68 years old; pachymetry 537 µm
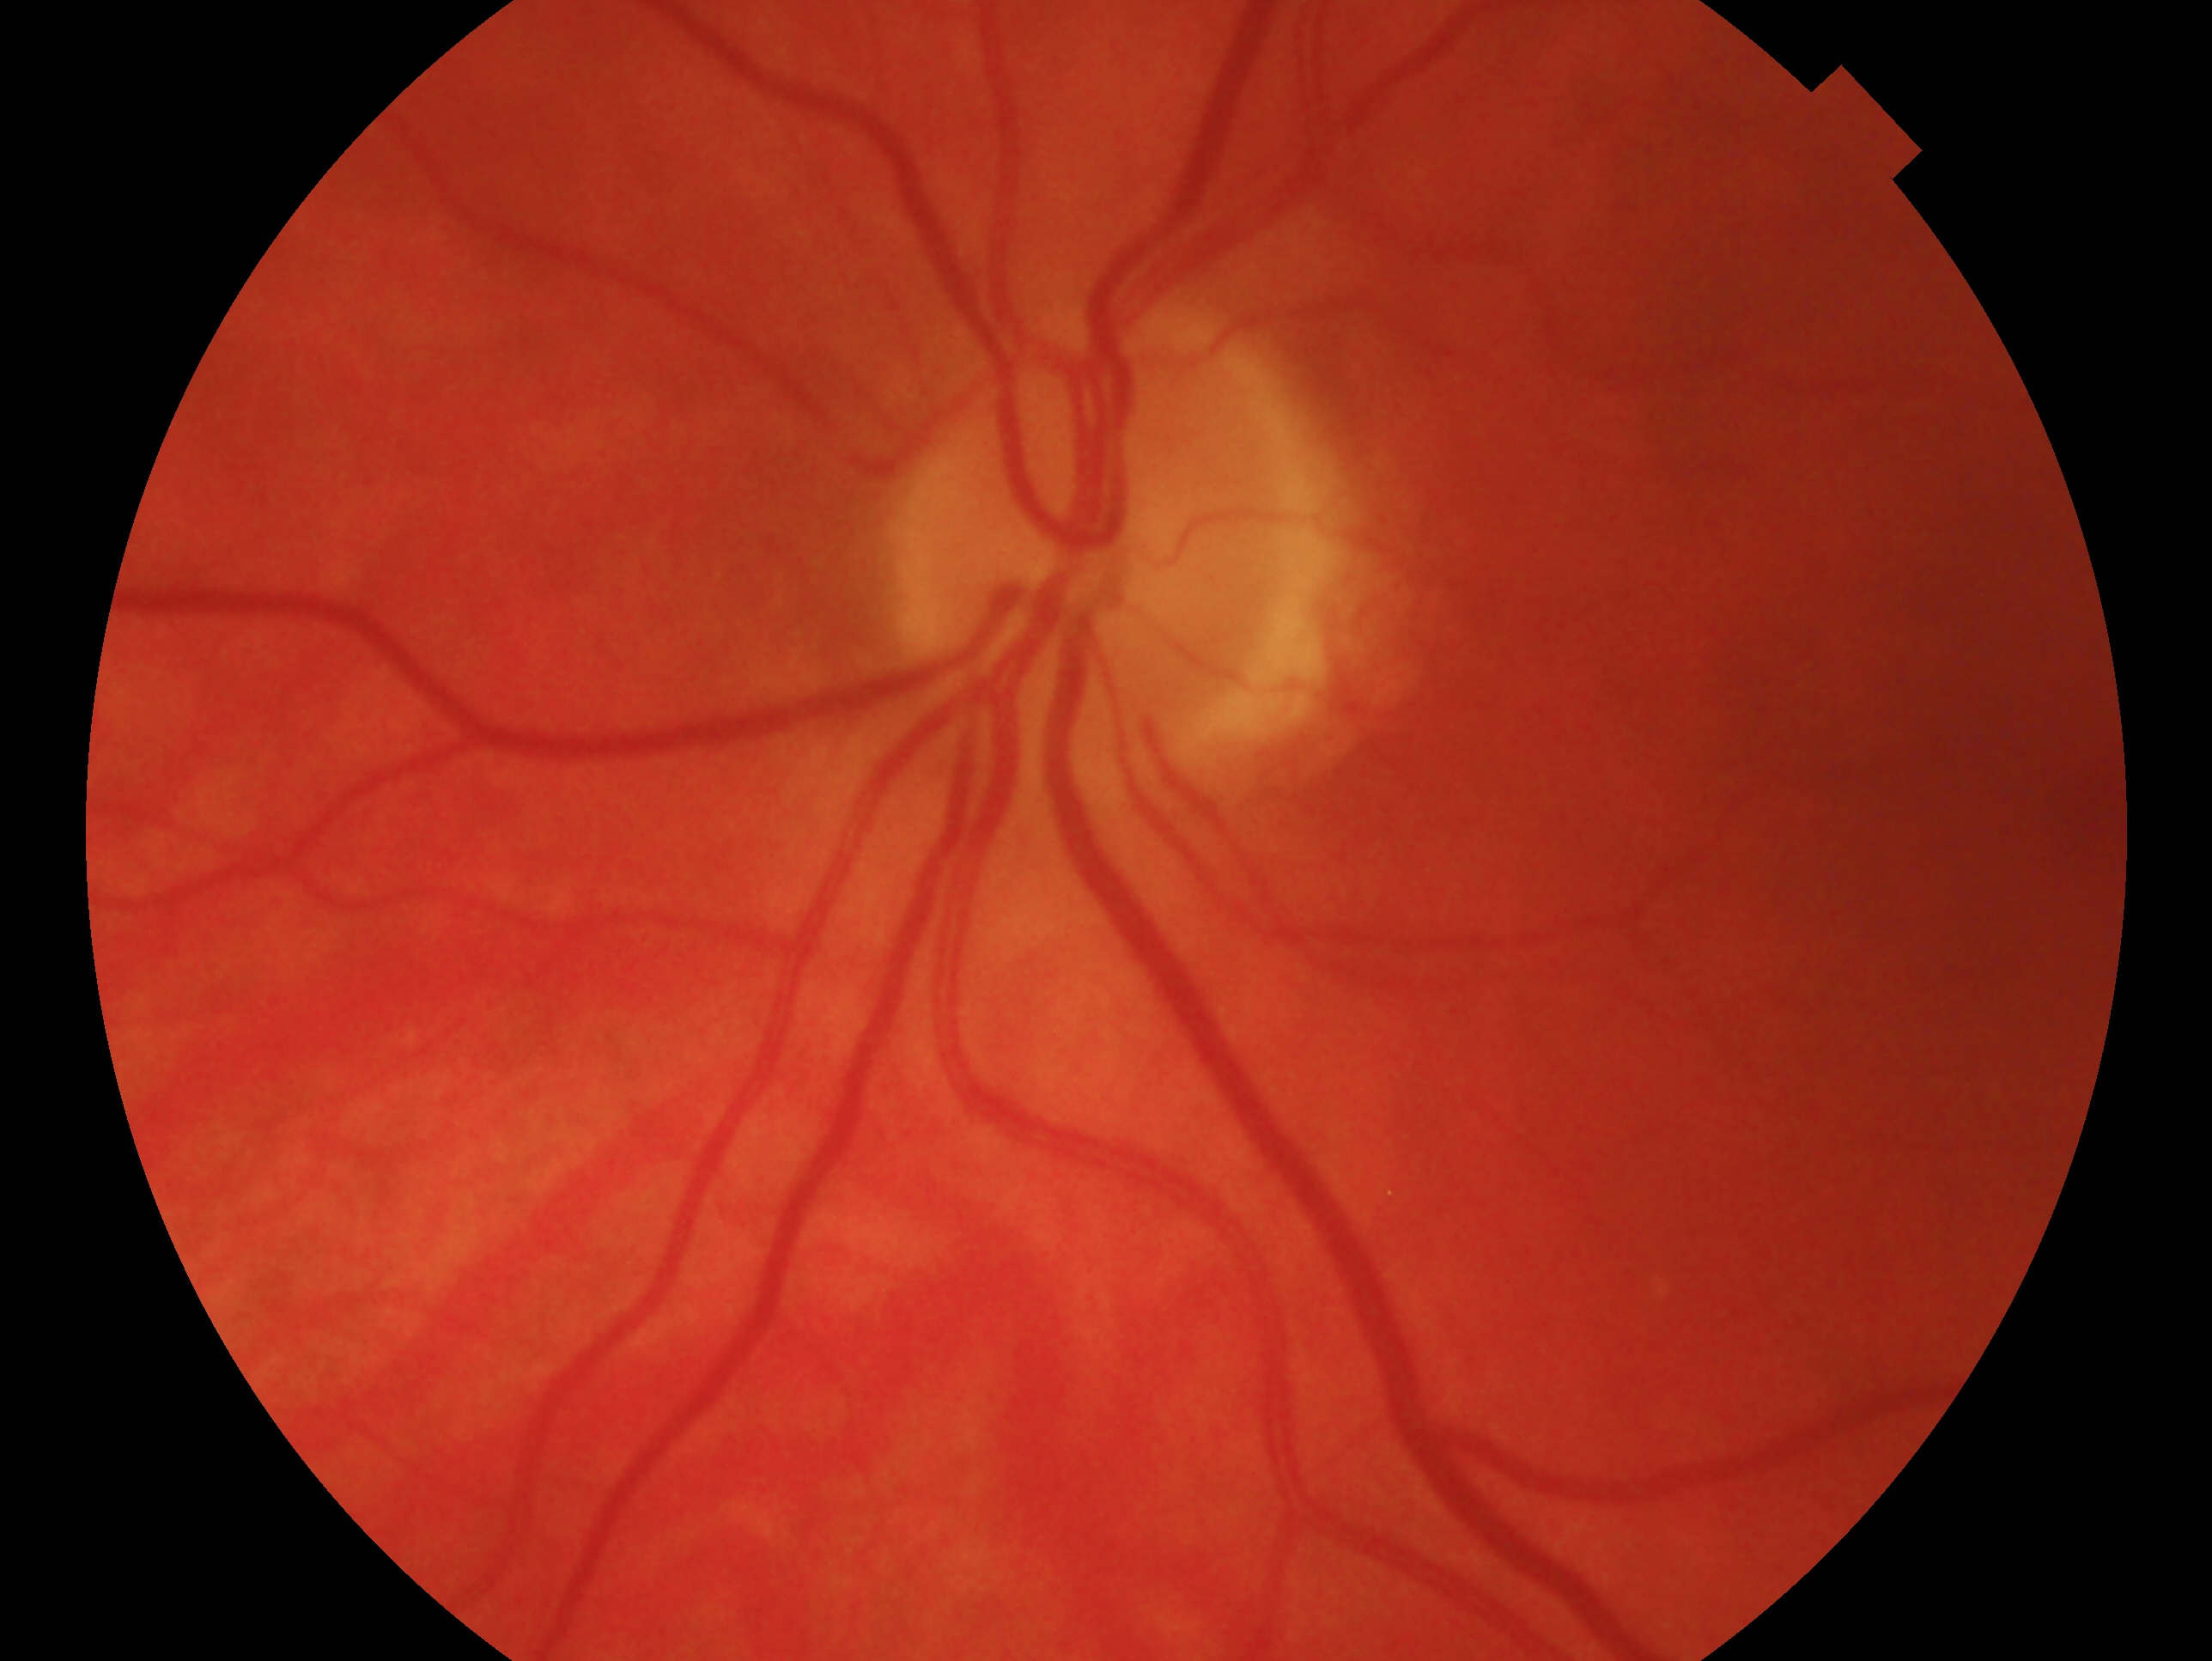

eye: left eye
glaucoma_dx: negative for glaucoma